Ultra-widefield (UWF) fundus image
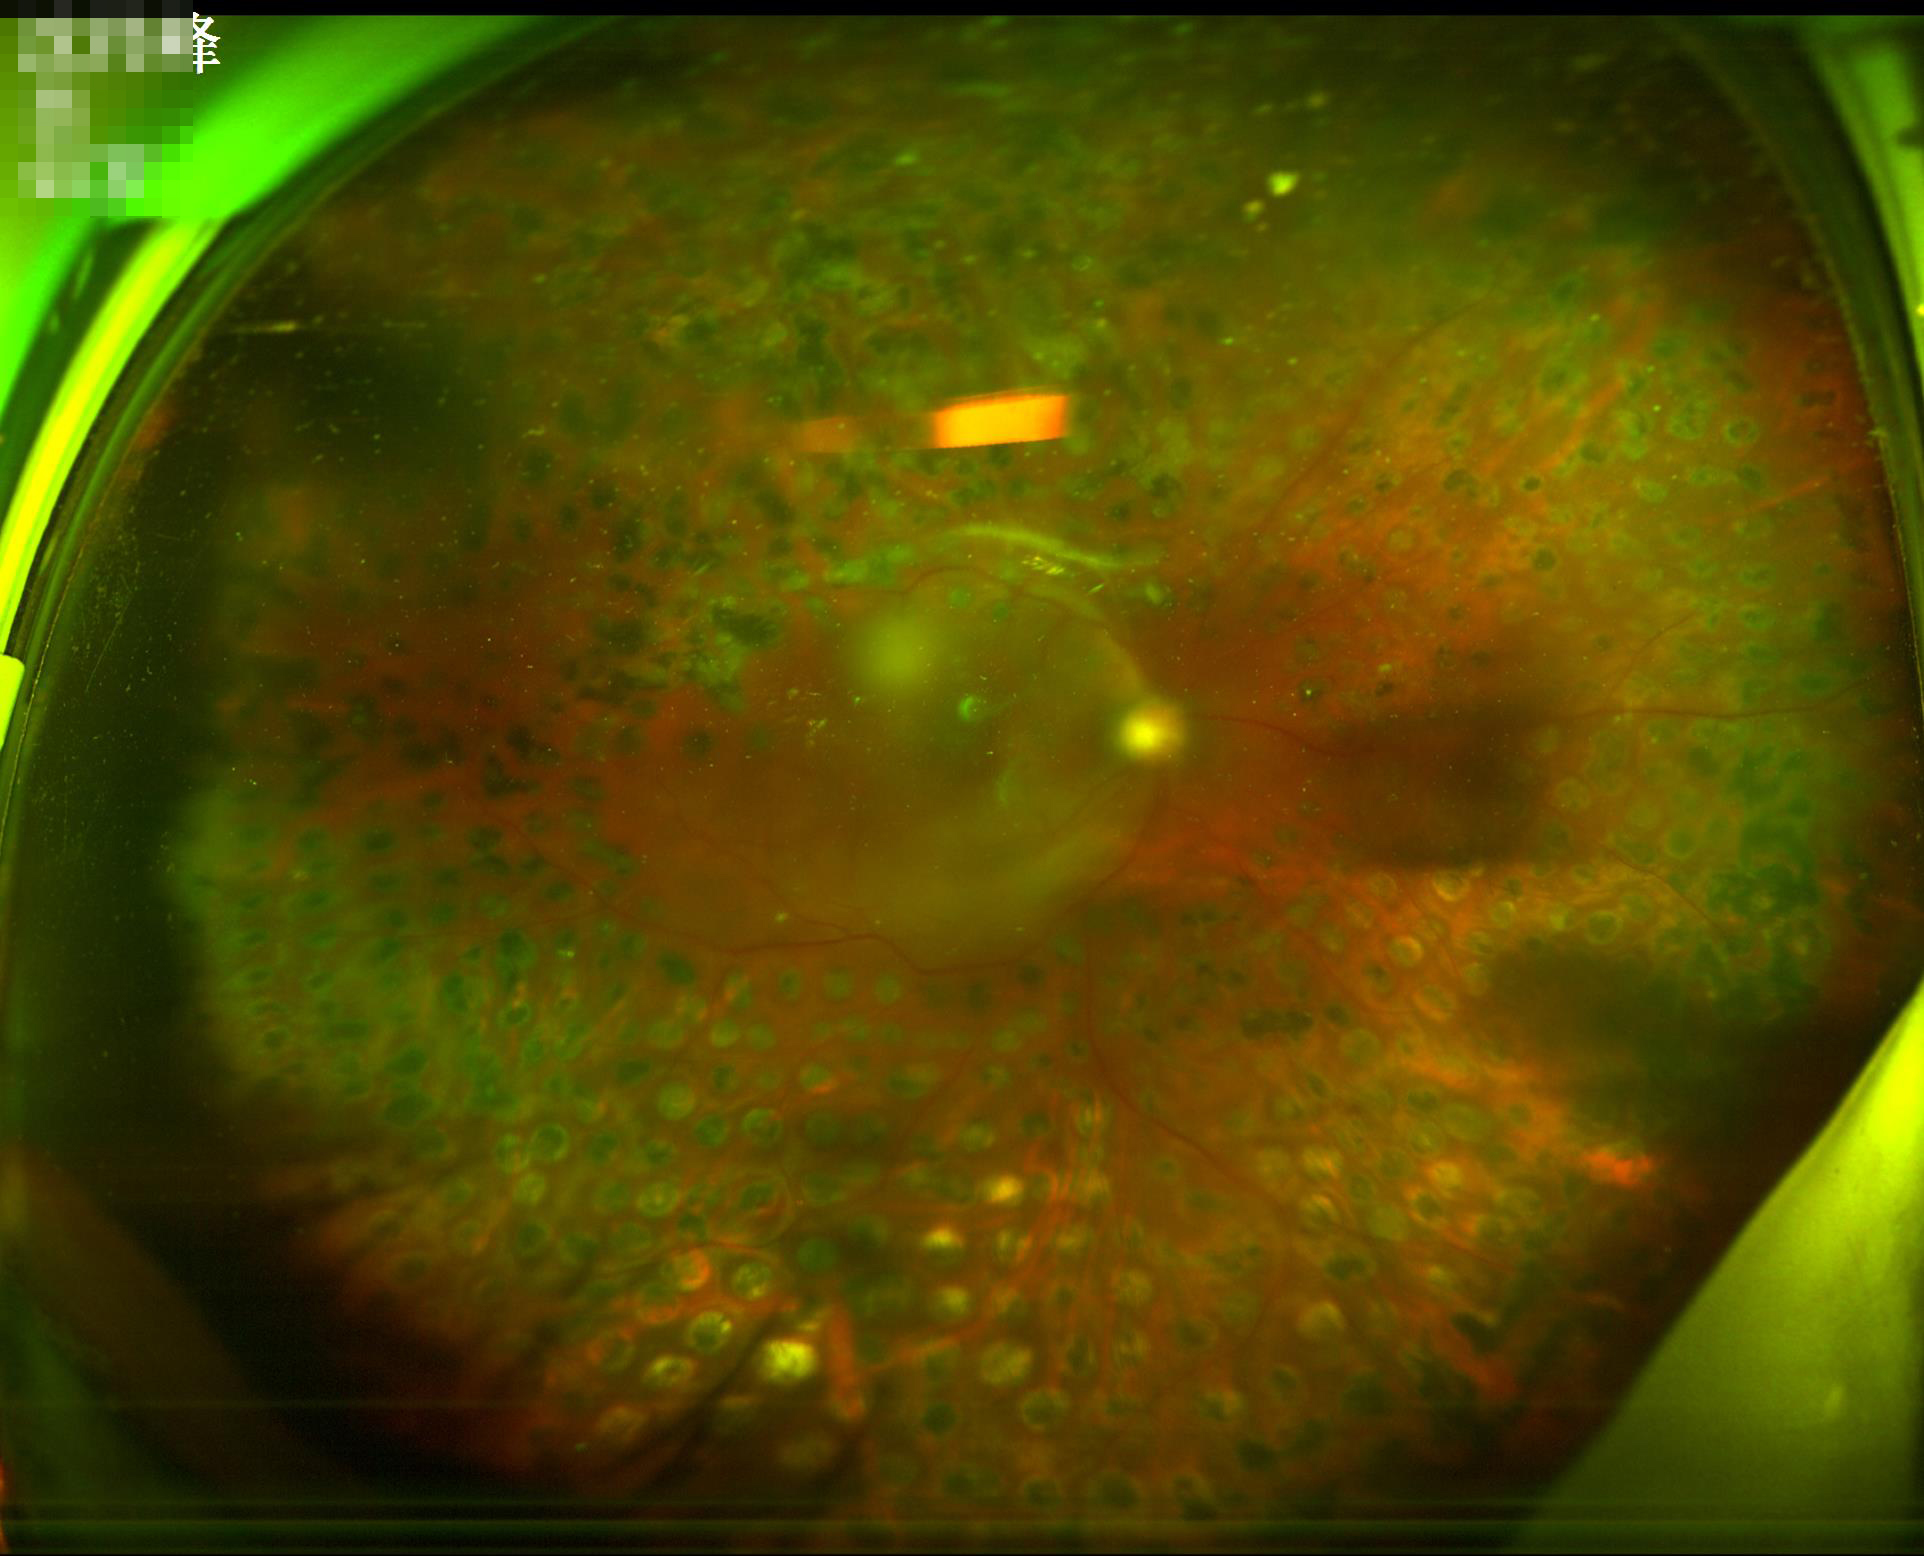

Image quality is inadequate for diagnostic use. There is over- or under-exposure or a color cast. Vessels and details are readily distinguishable. Out of focus; structures are indistinct.